45° field of view, 1470 x 1137 pixels, CFP.
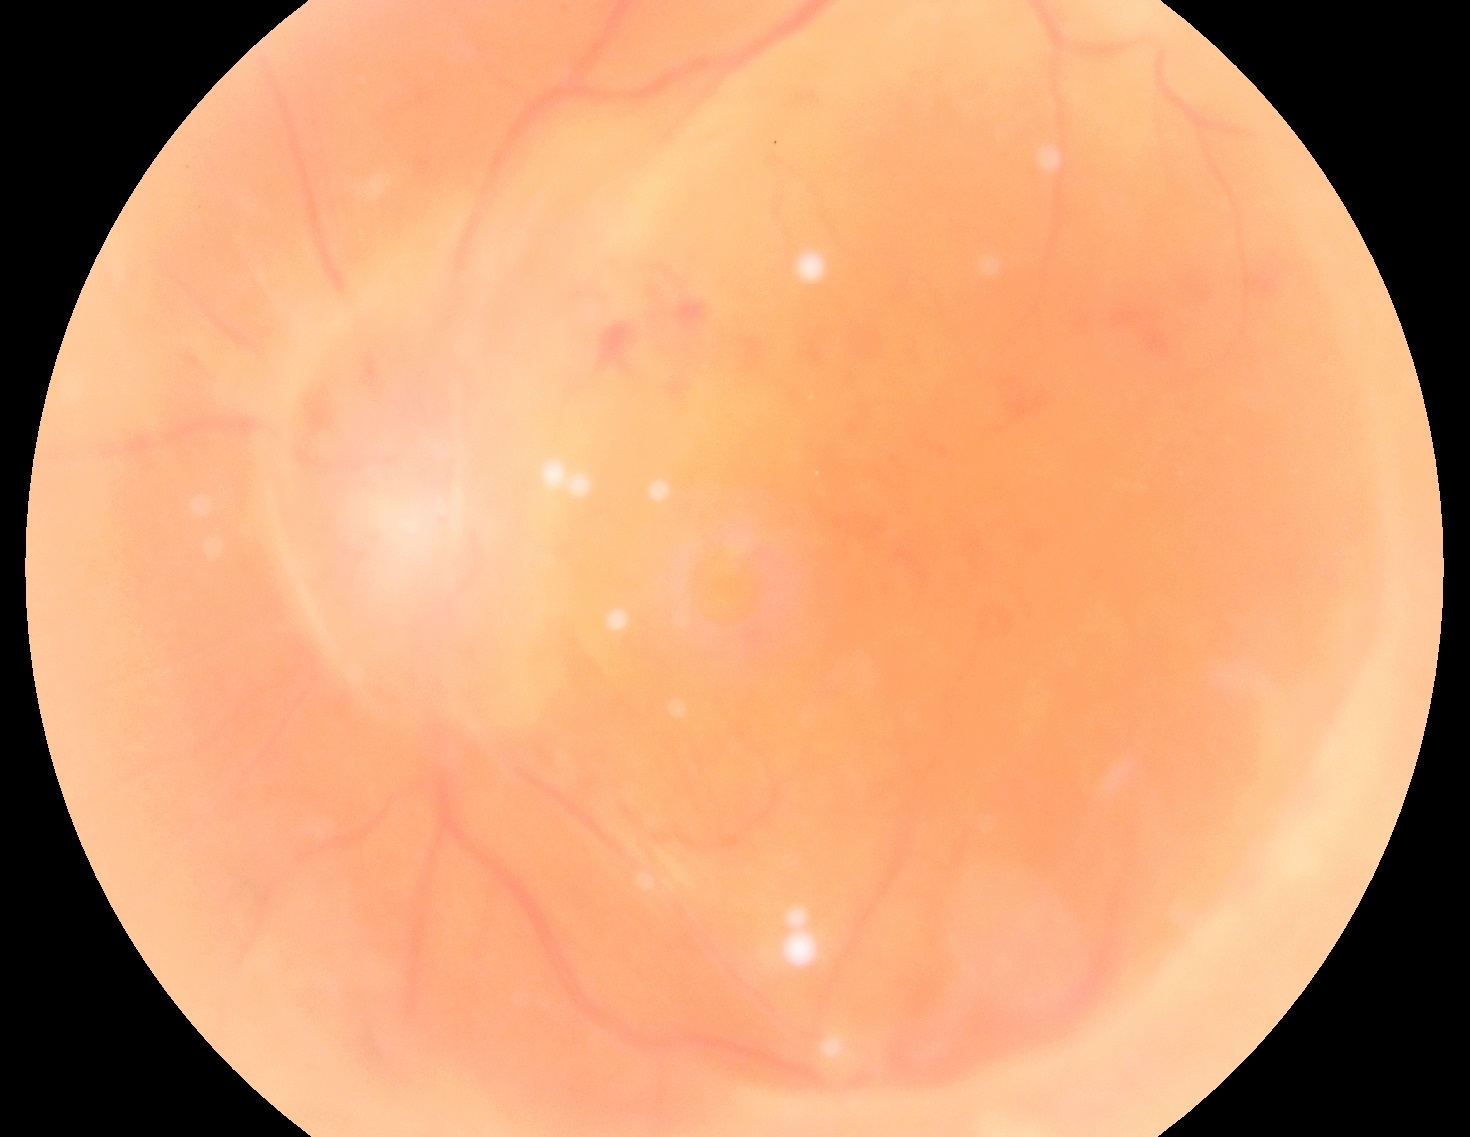

Diabetic retinopathy severity: grade 4 (PDR).